Wide-field fundus photograph from neonatal ROP screening; 1240x1240px
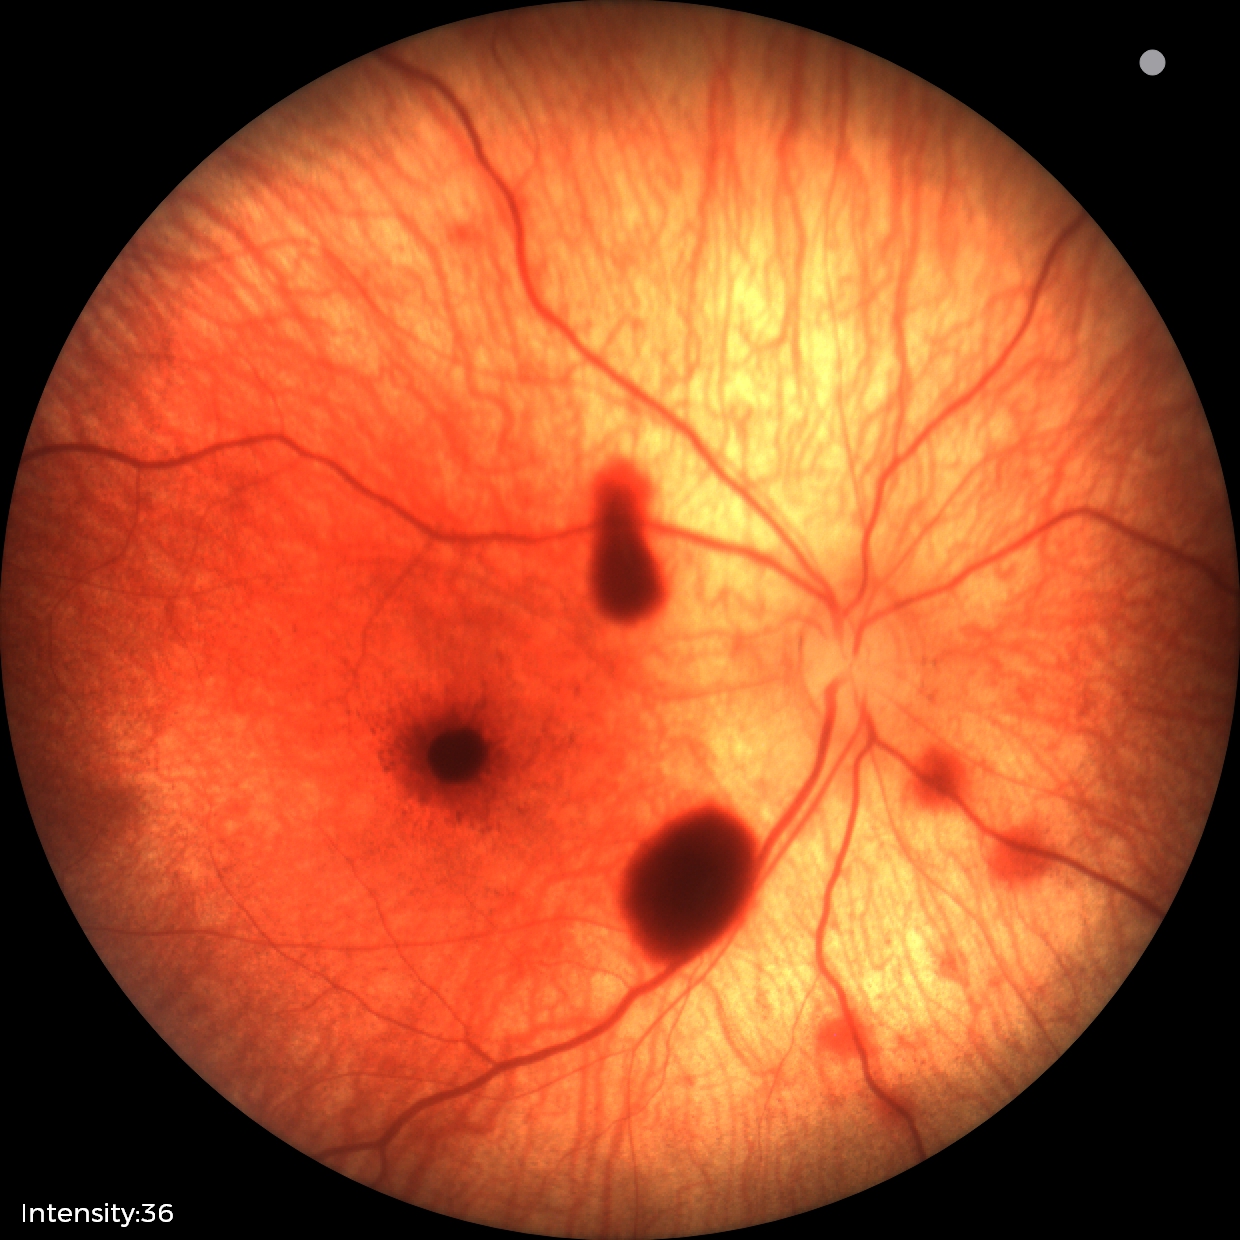
Series diagnosed as retinal hemorrhages.